Color fundus image · image size 768x576: 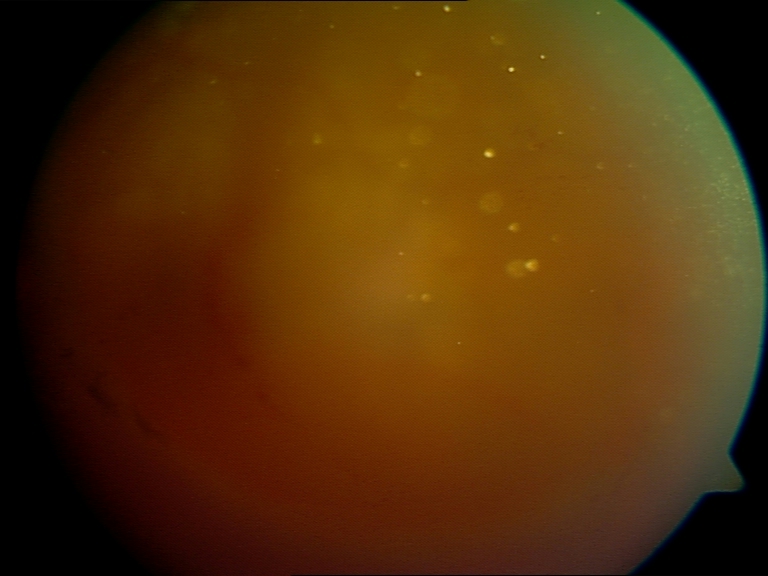
Image quality is poor; more than half the field is obscured. No evidence of proliferative diabetic retinopathy.